Infant wide-field retinal image: 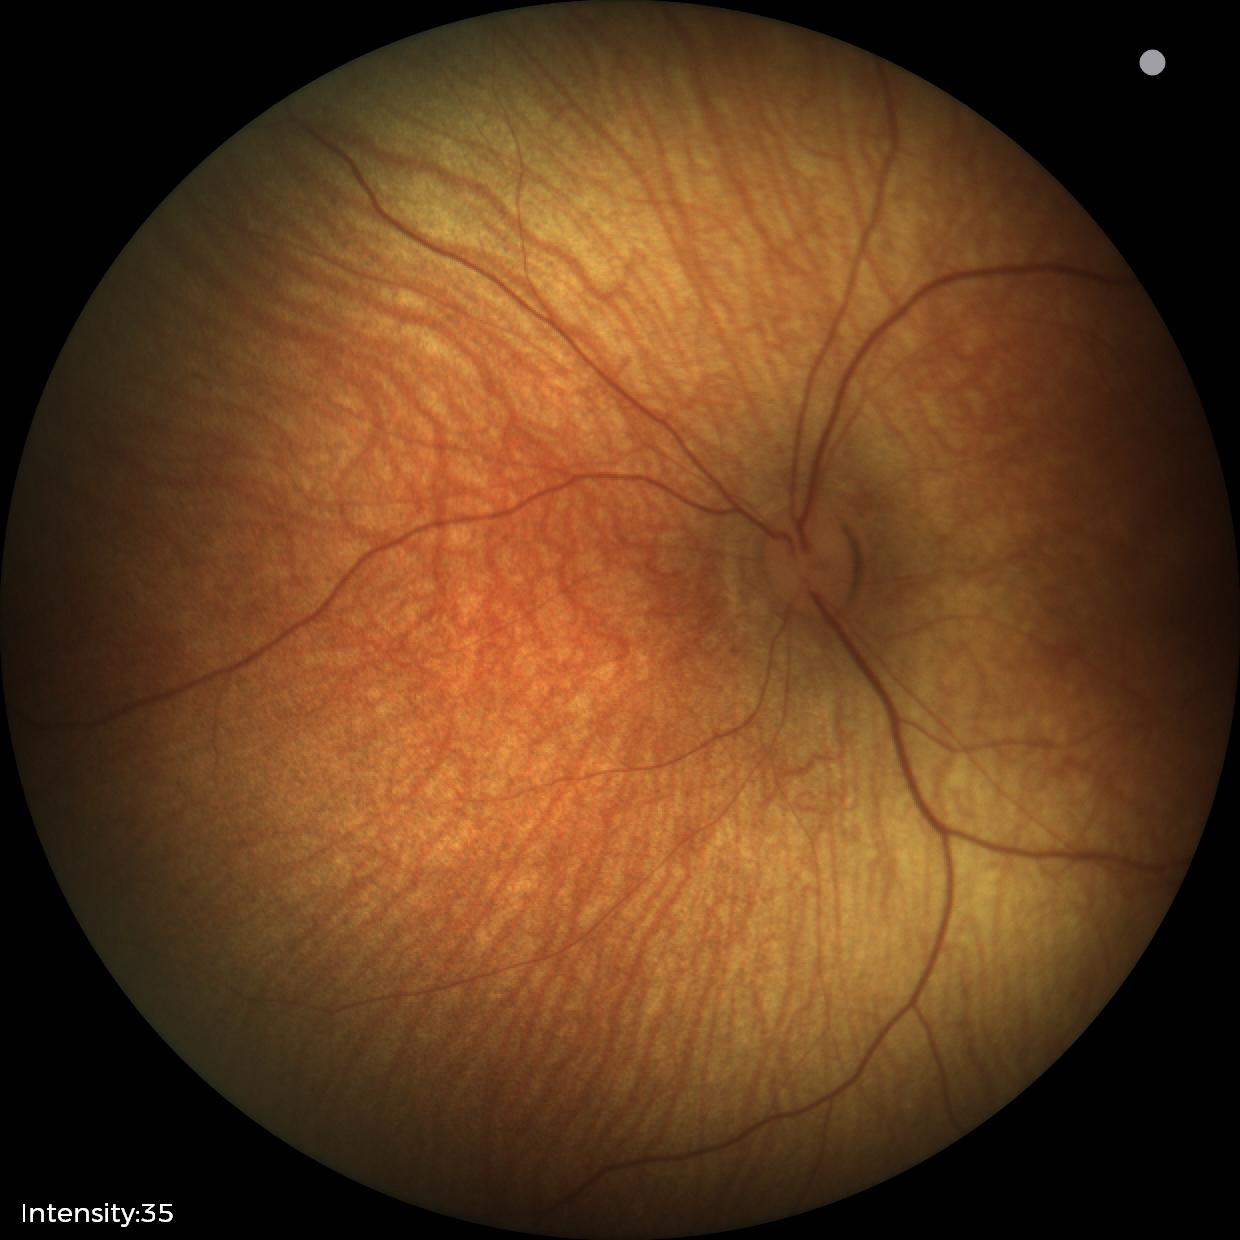
Examination with physiological retinal findings.